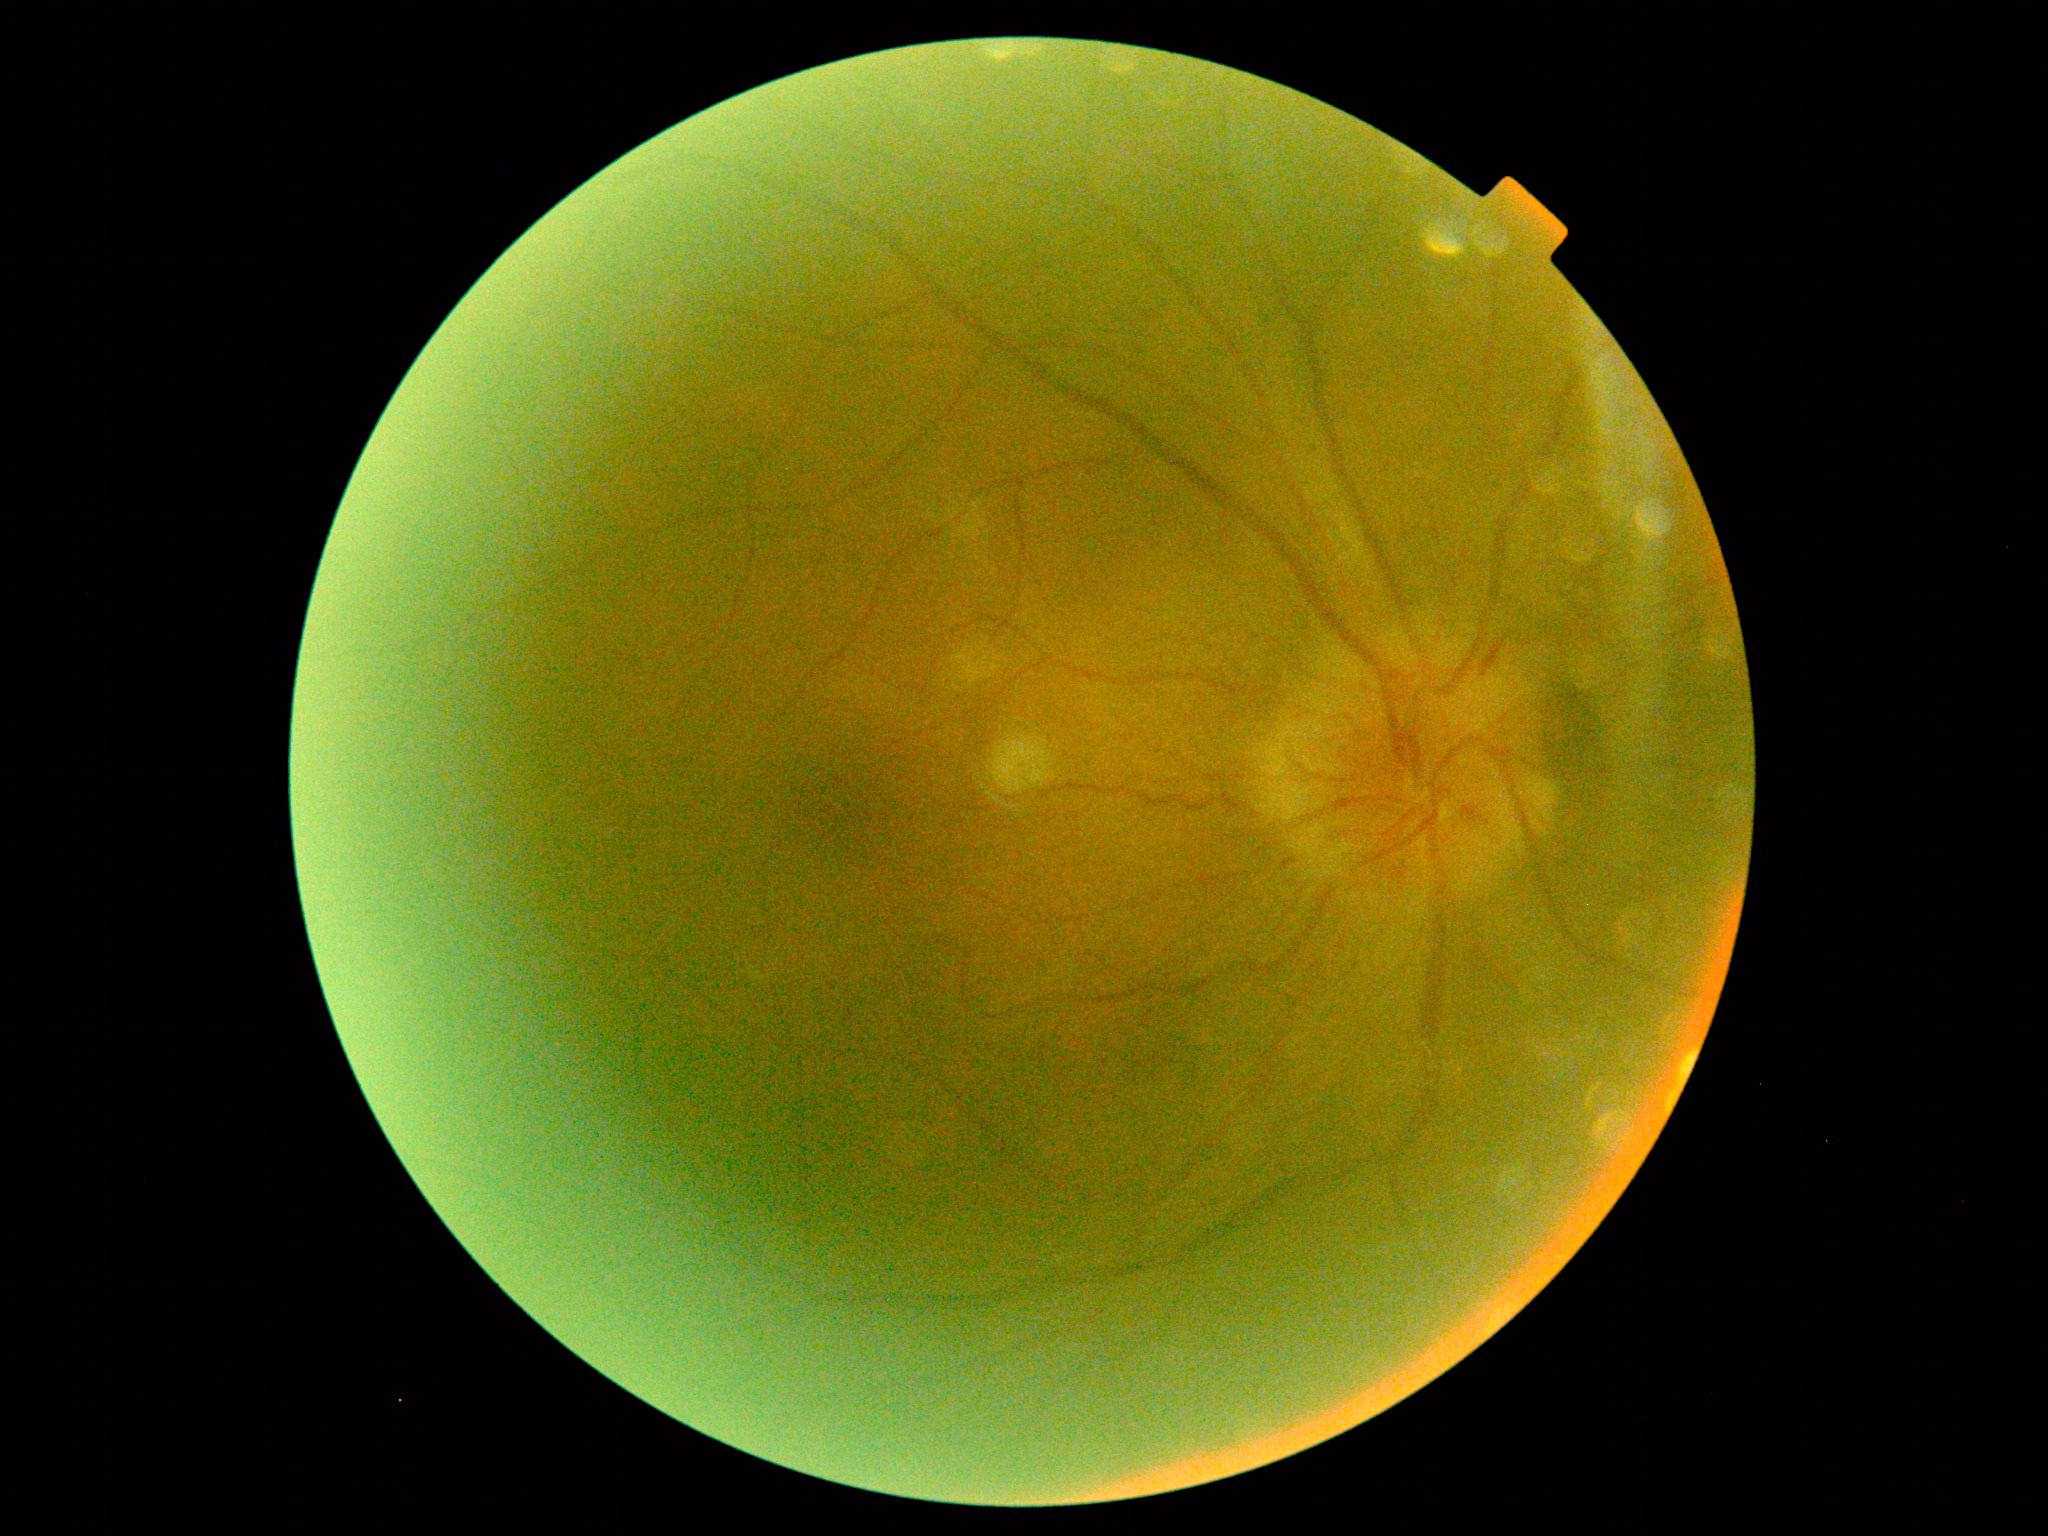 Diabetic retinopathy severity is 2 — more than just microaneurysms but less than severe NPDR.